1932x1932 — 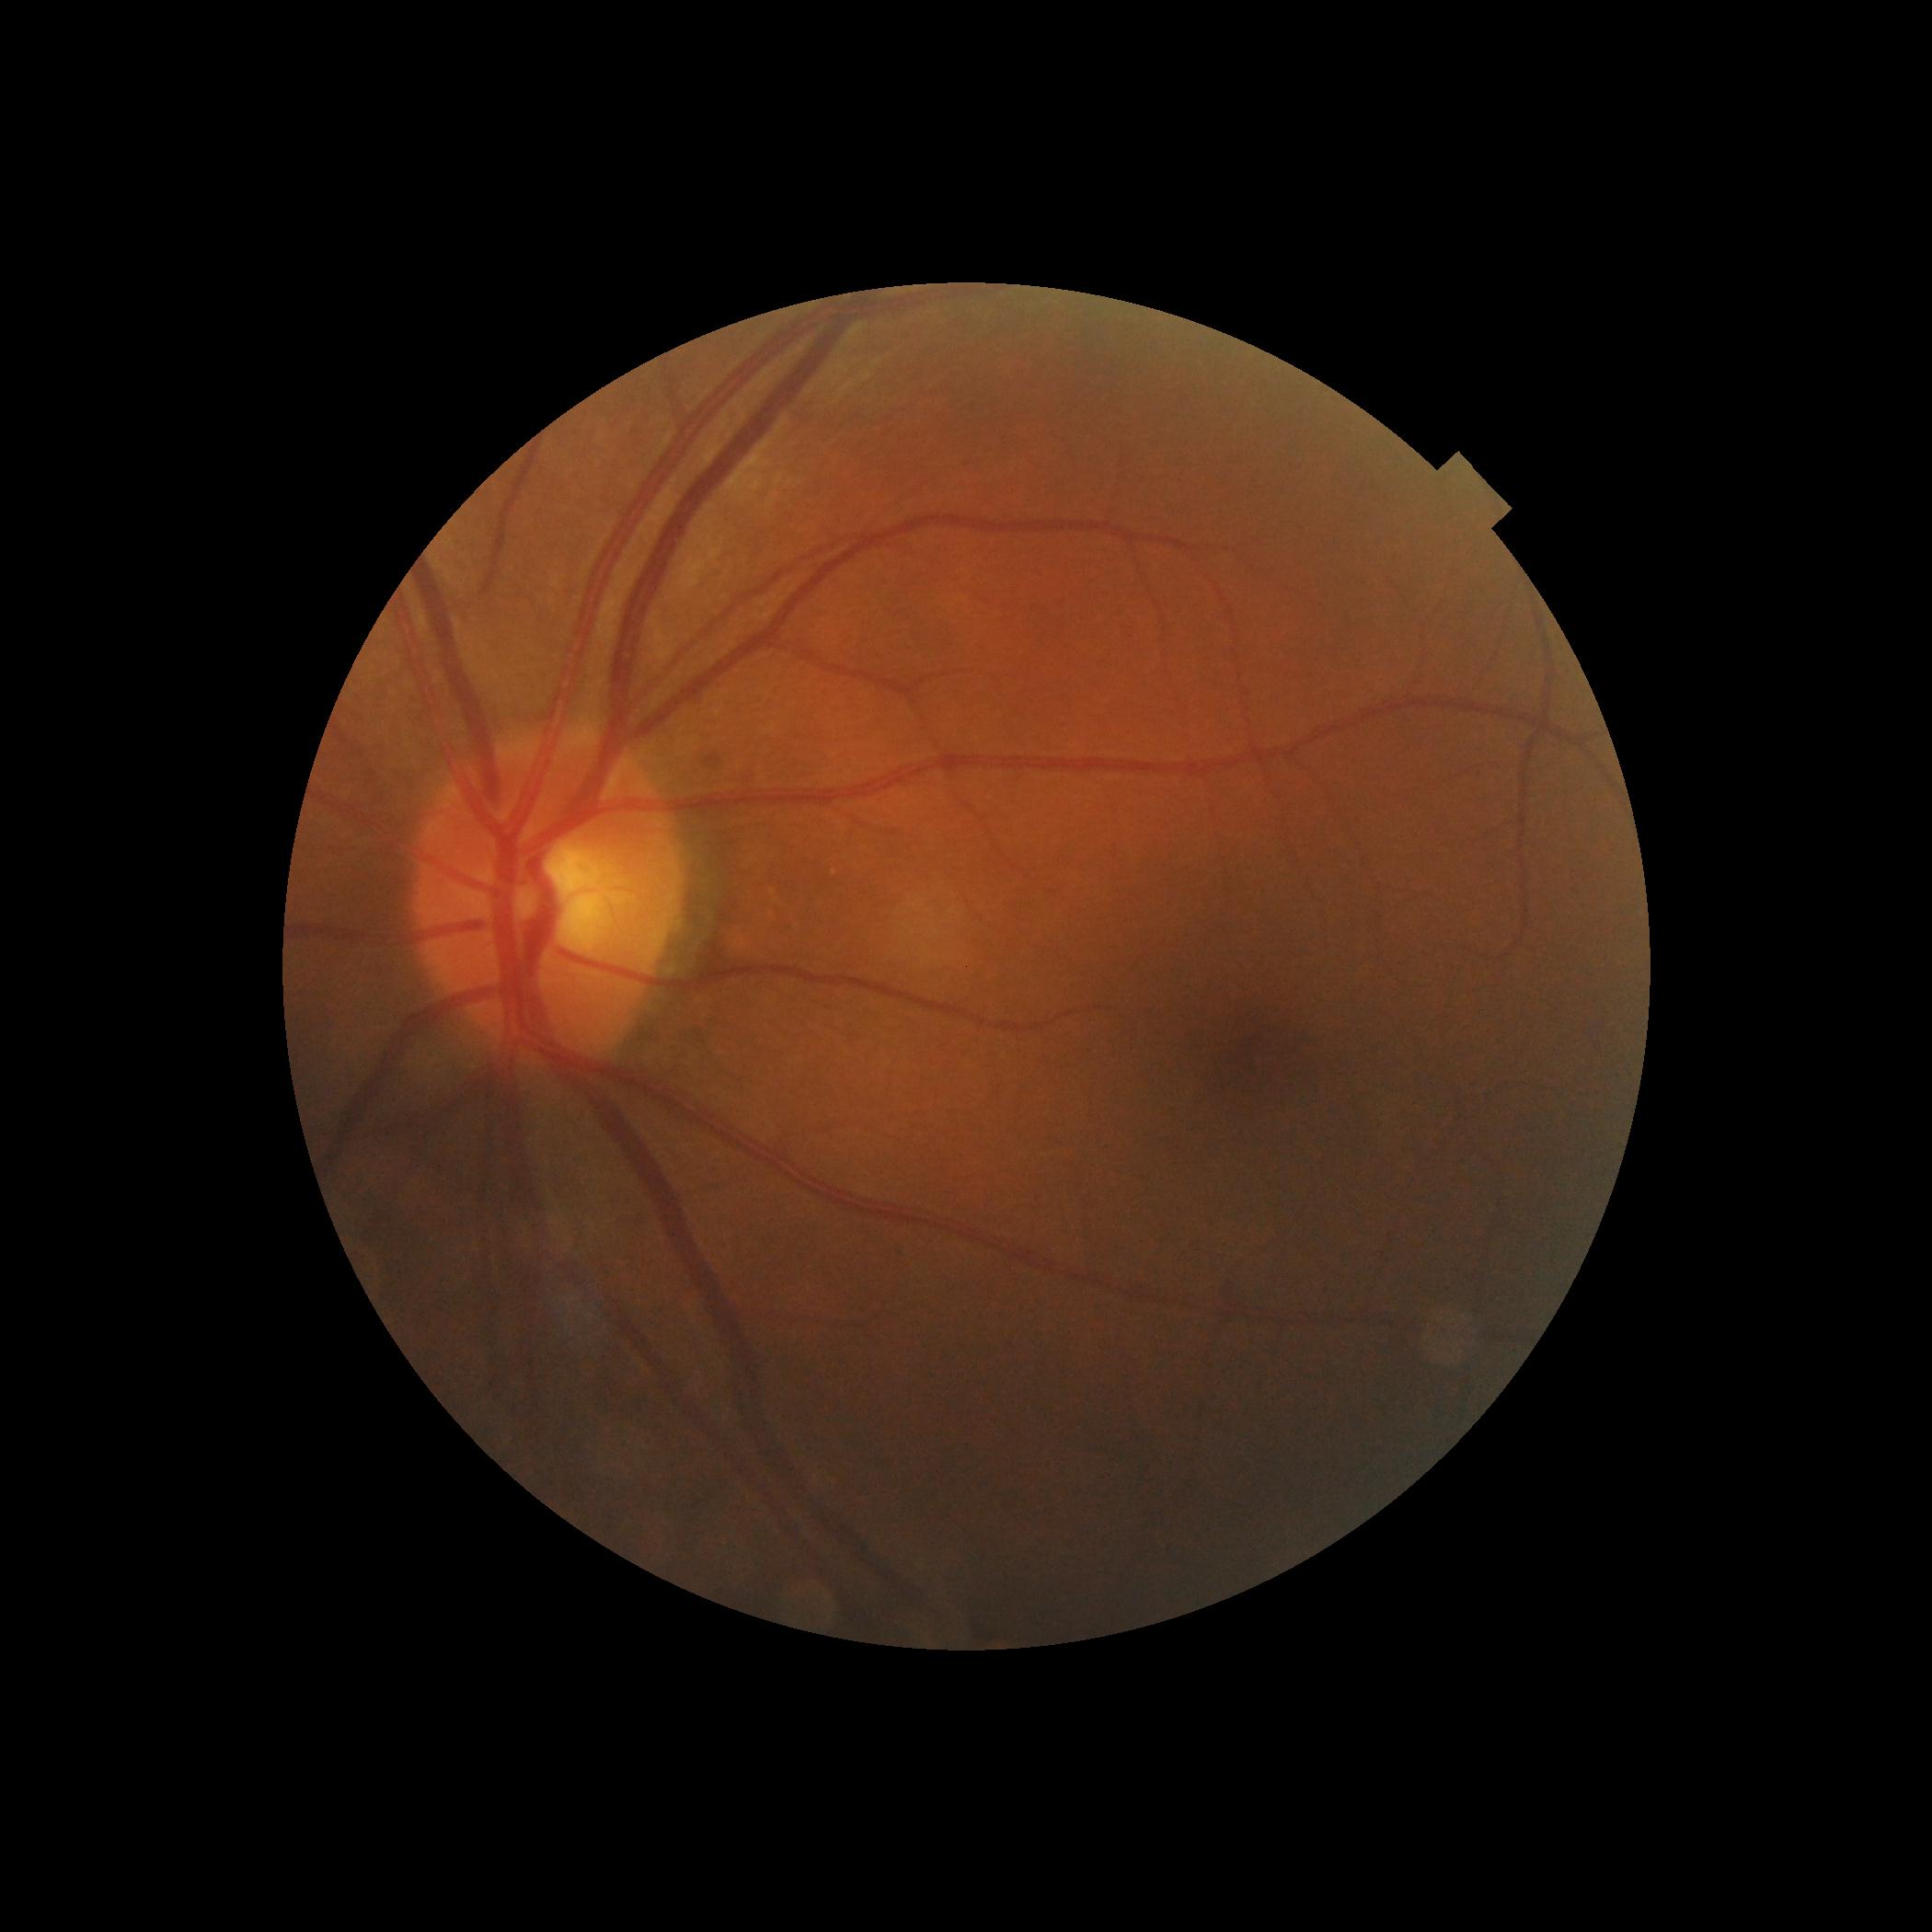 DR: no apparent retinopathy (grade 0).